Retinal fundus photograph · 2352x1568 — 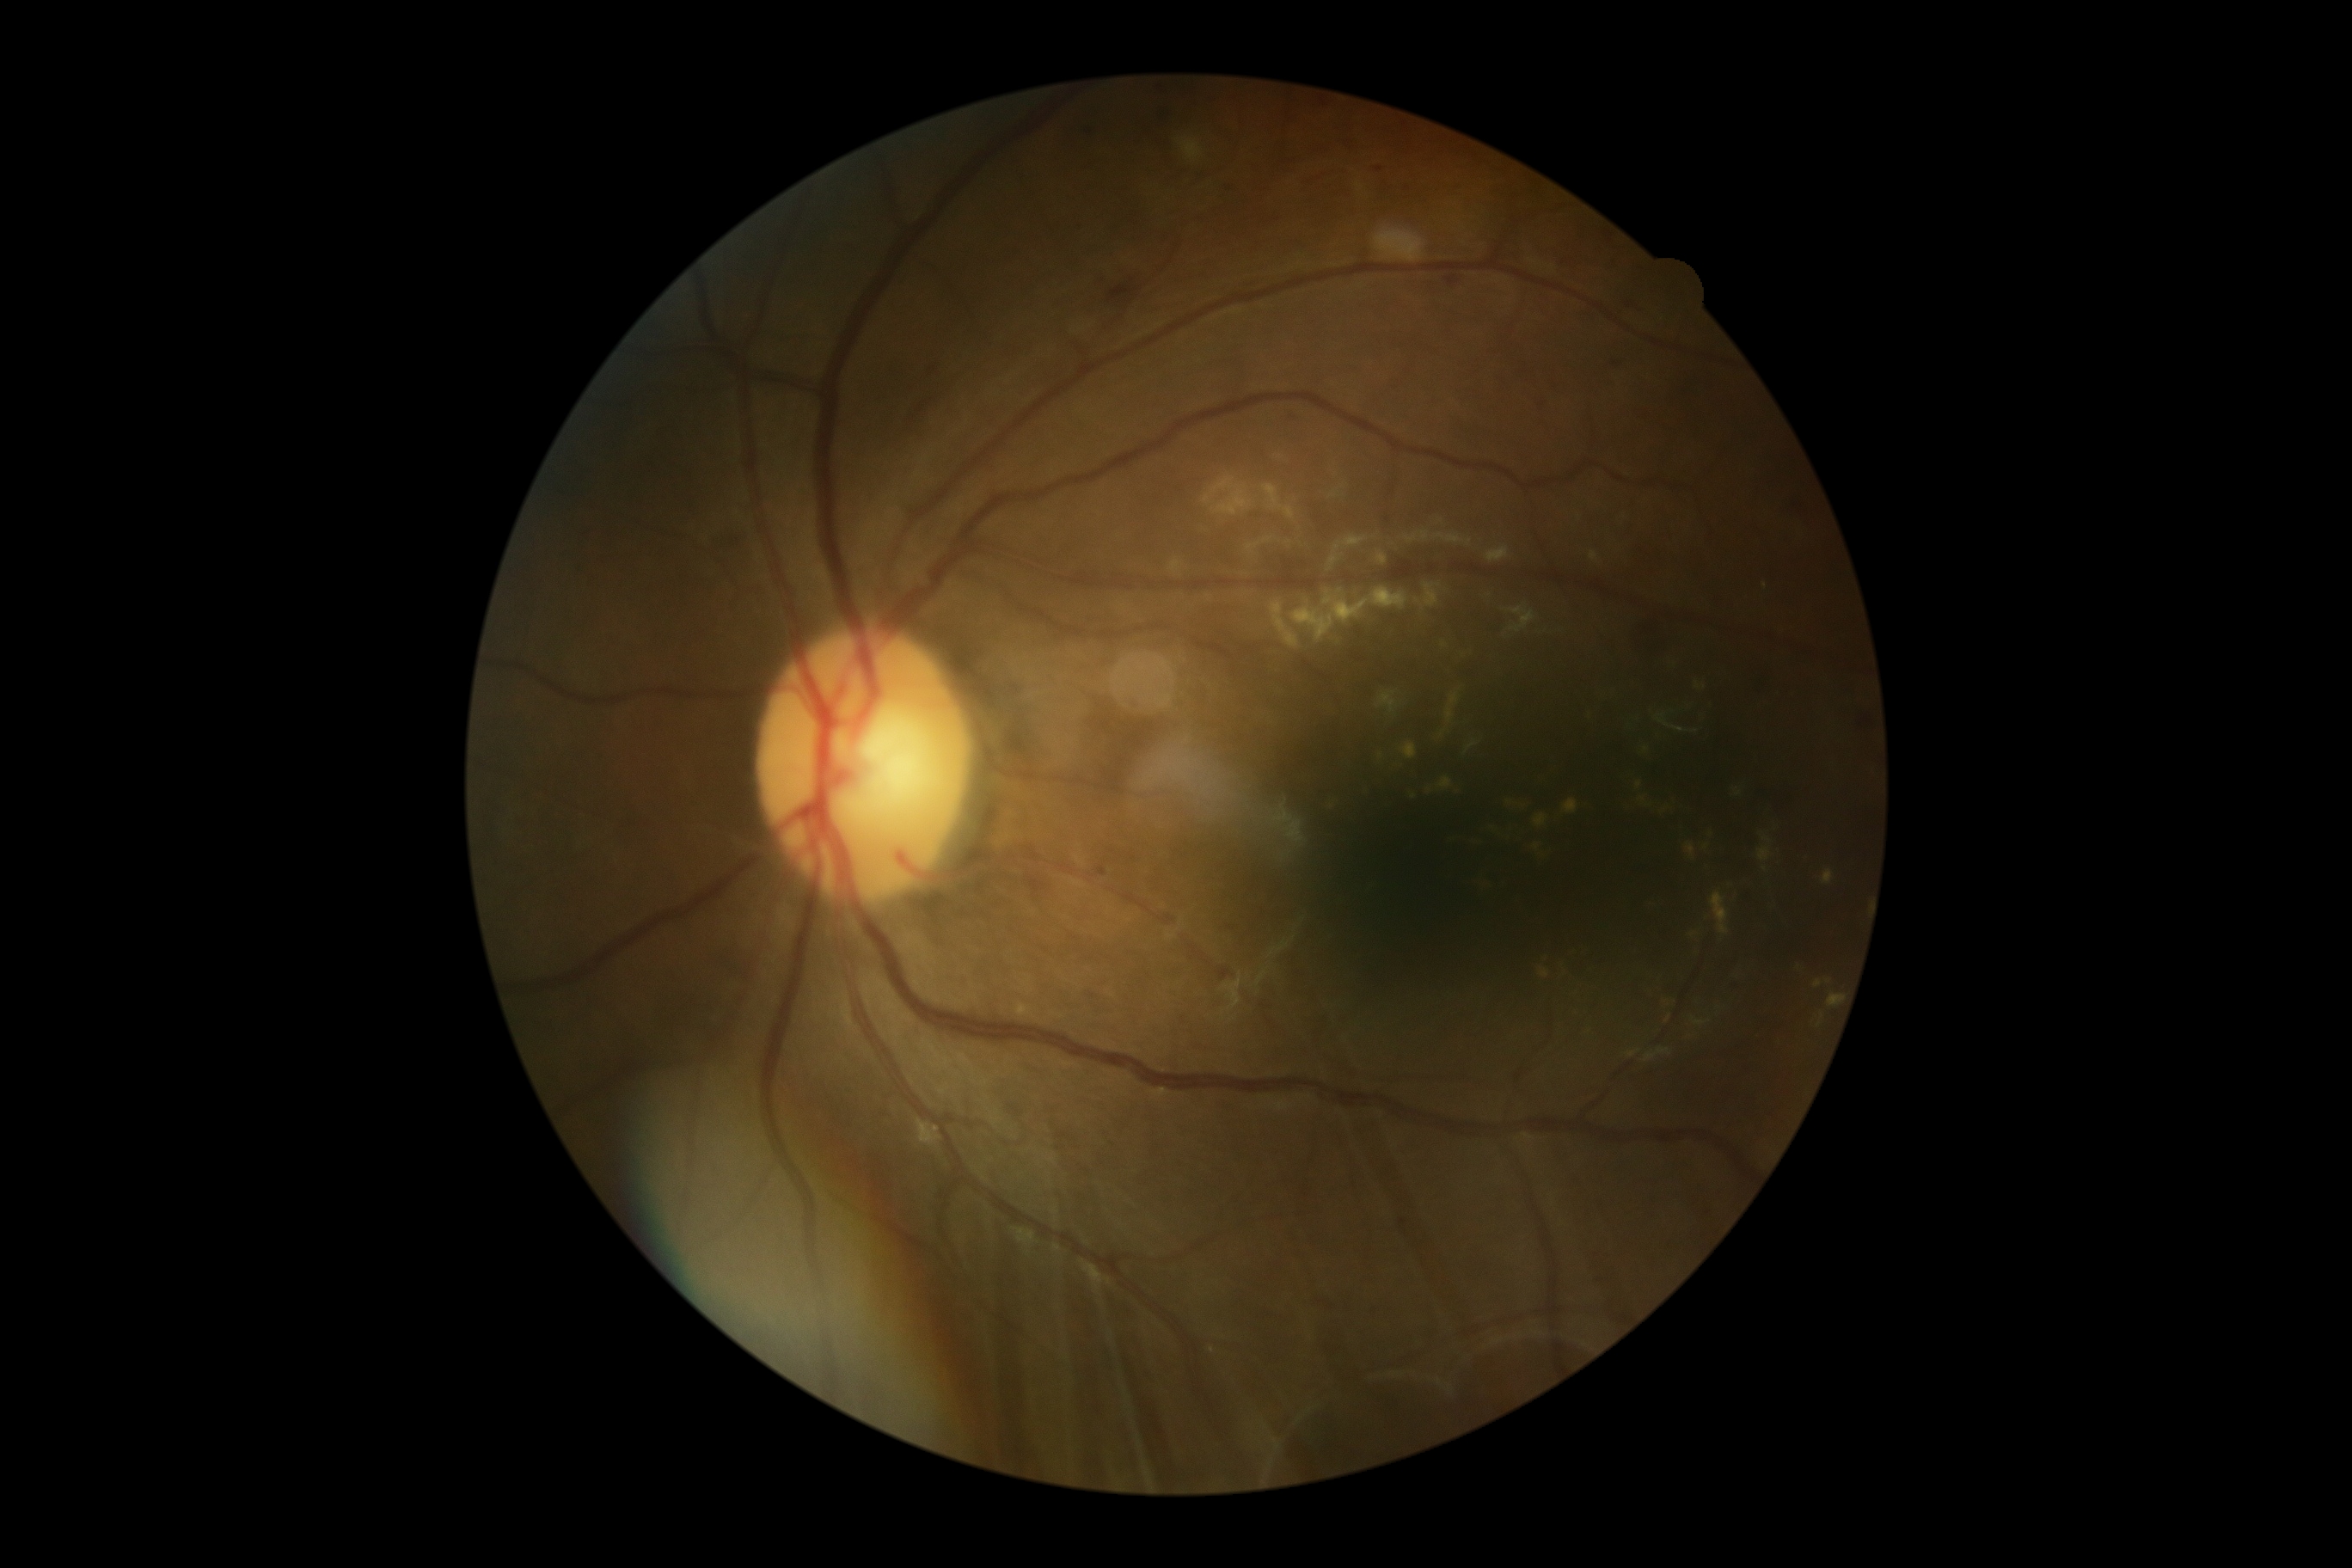
diabetic retinopathy (DR) = grade 2 (moderate NPDR) | DR class = non-proliferative diabetic retinopathy.